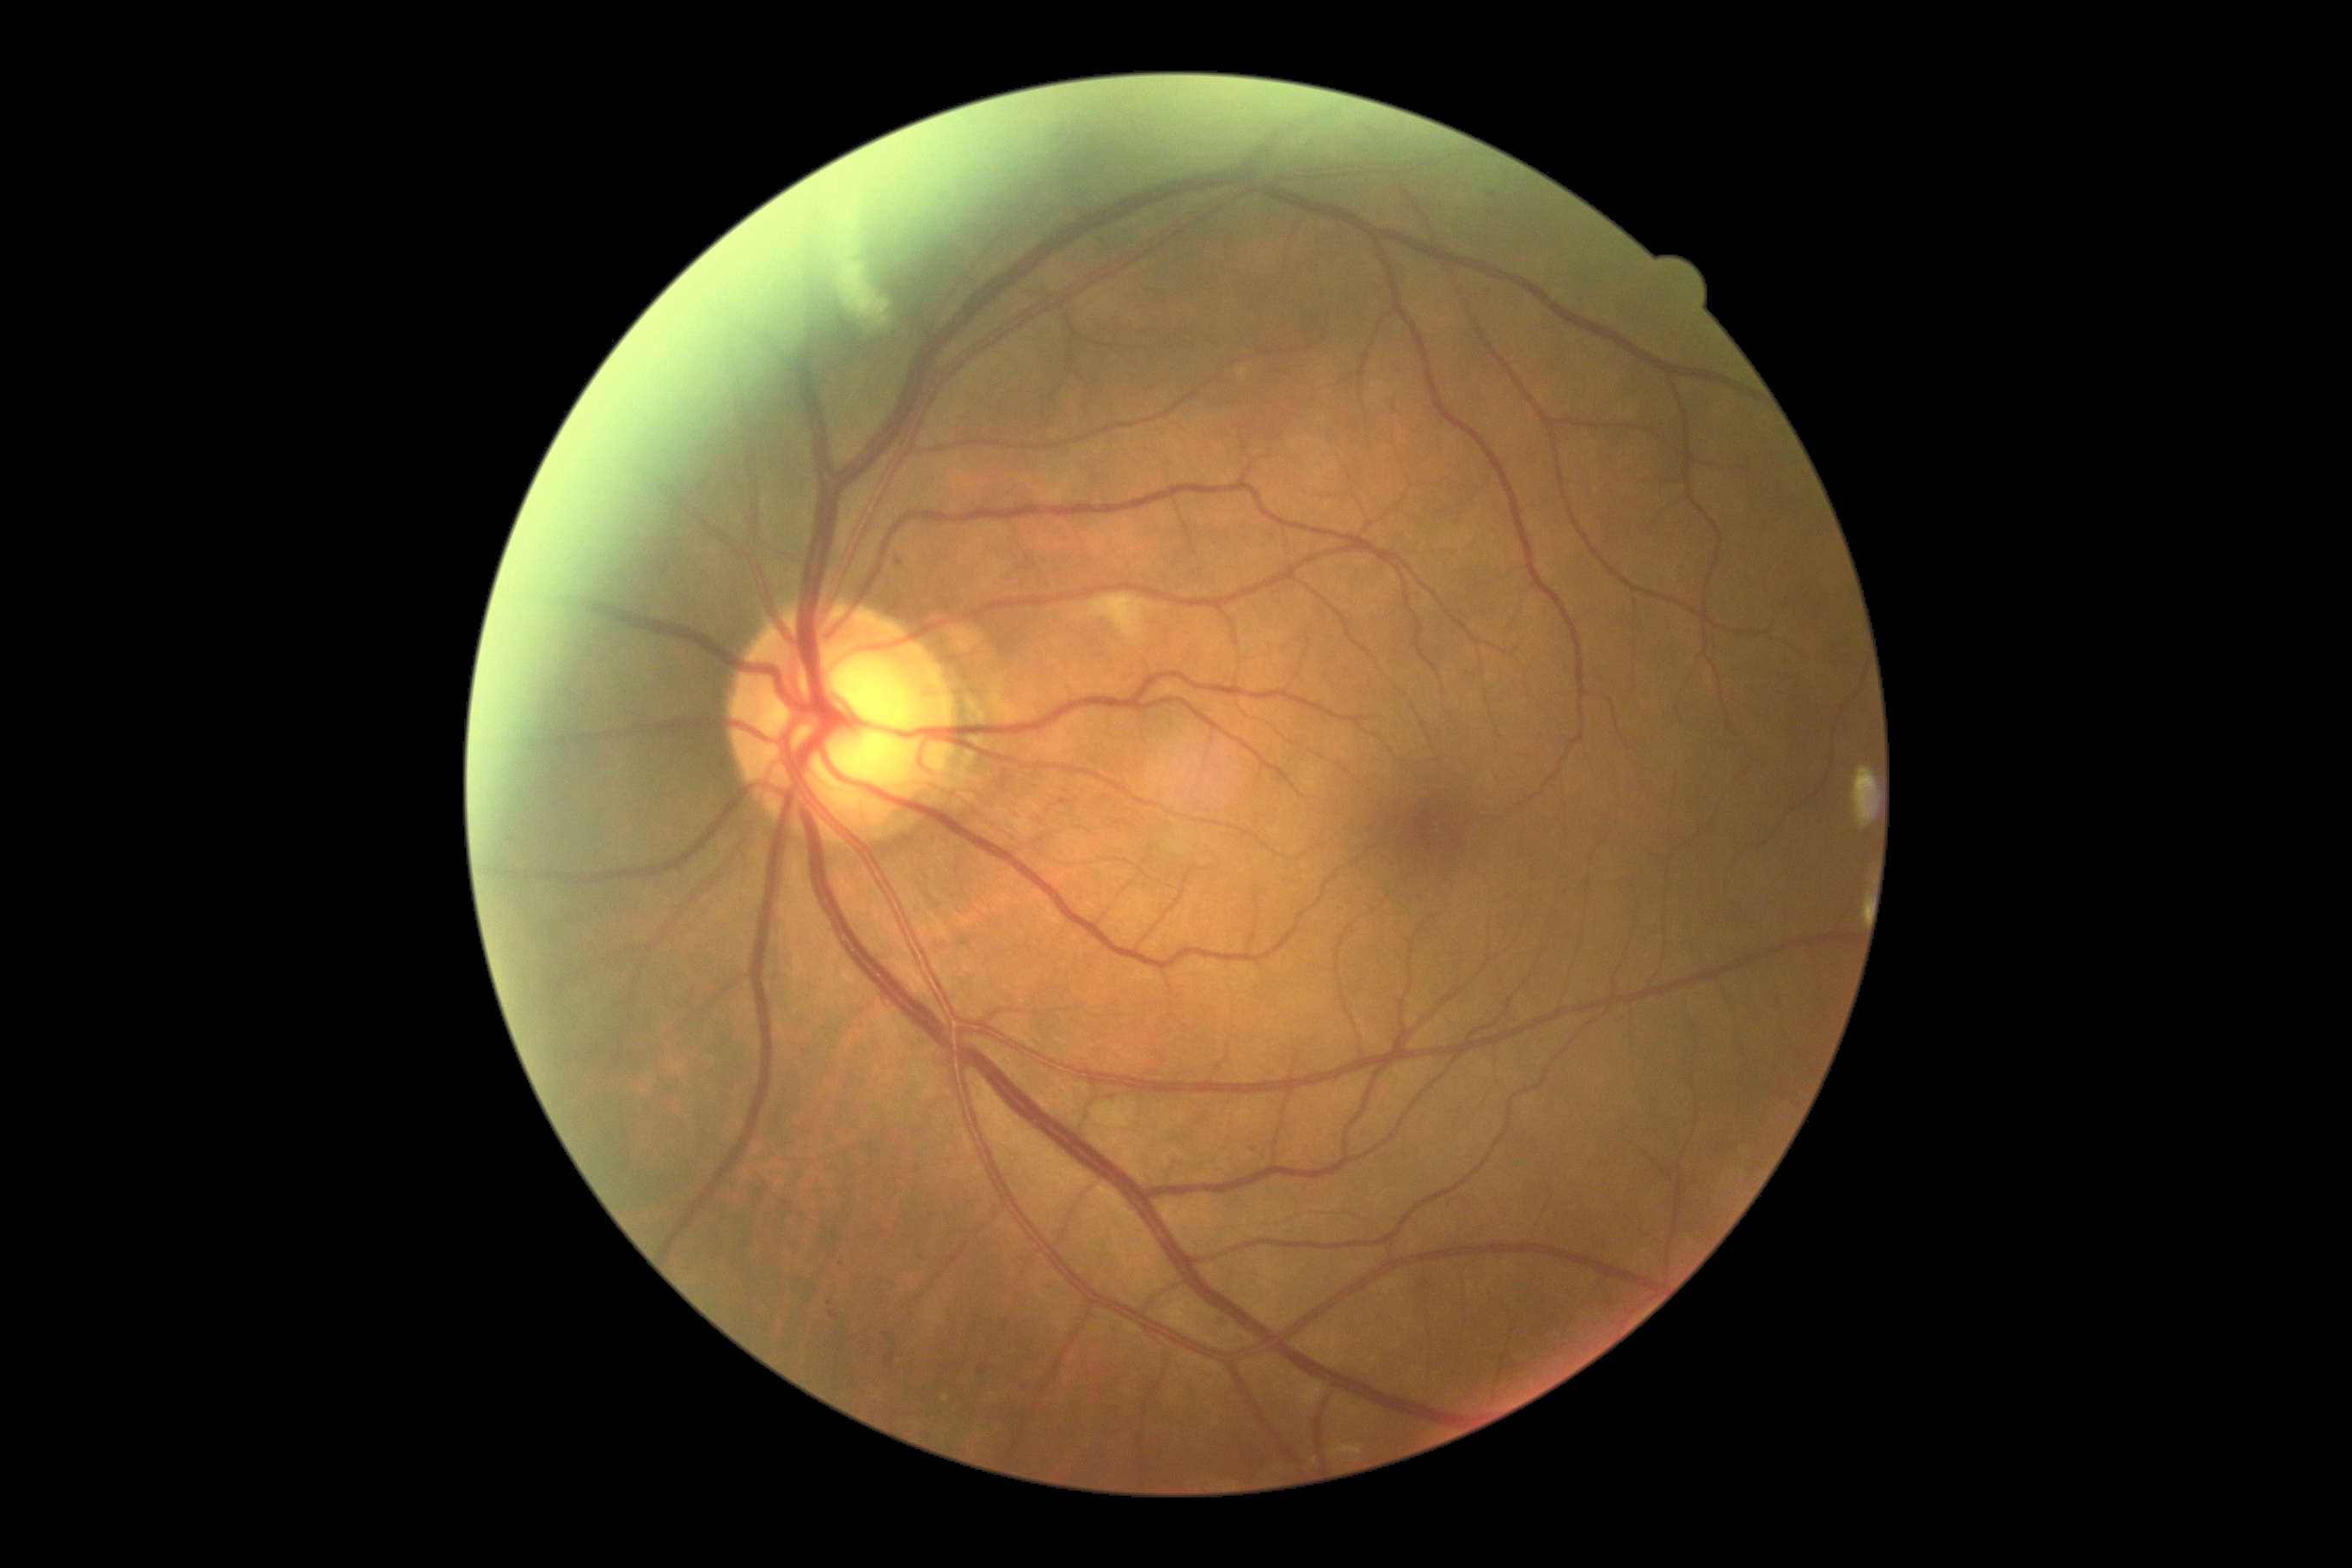

Annotations:
* DR: 2/4